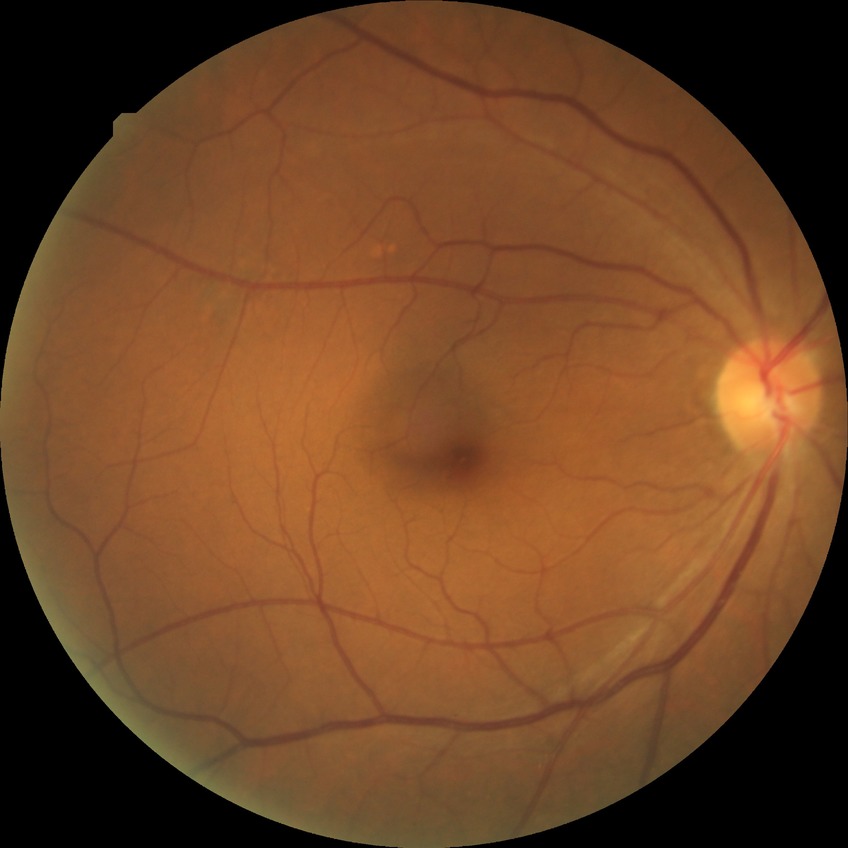
{"davis_grade": "no diabetic retinopathy"}